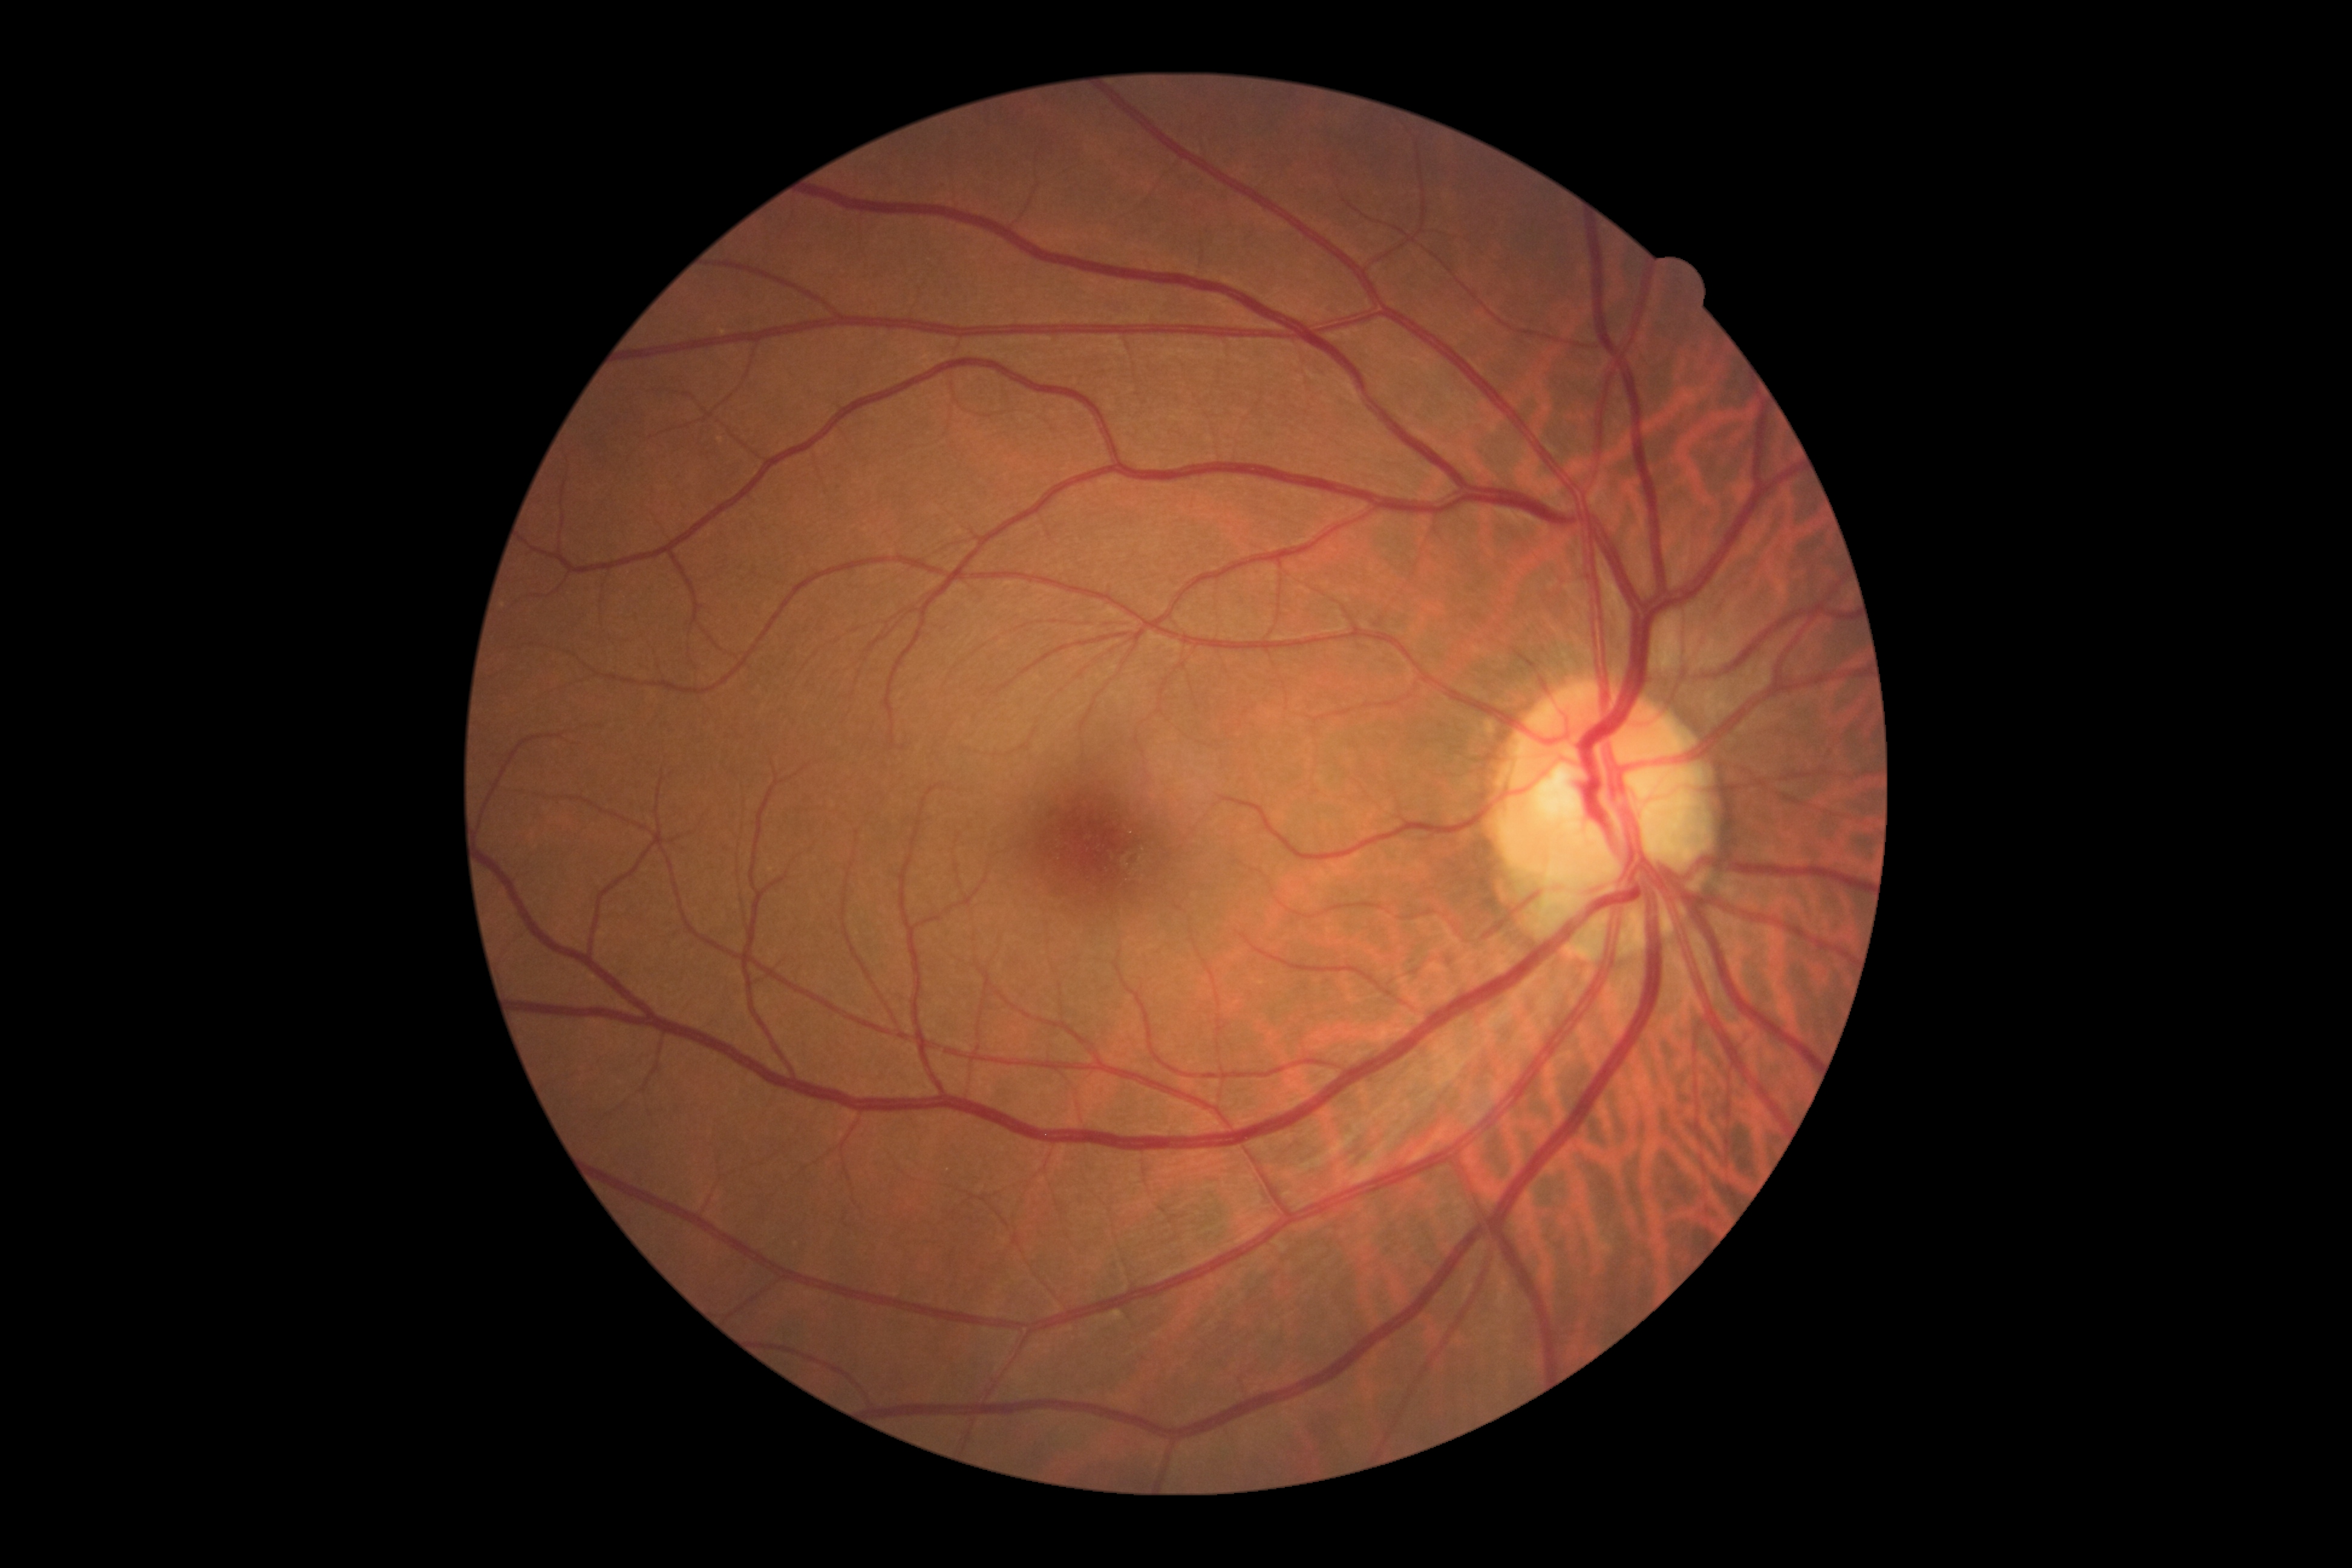

DR stage is grade 0.